Gender: M; age 67; autorefraction: +4.25 -3.5 x 103
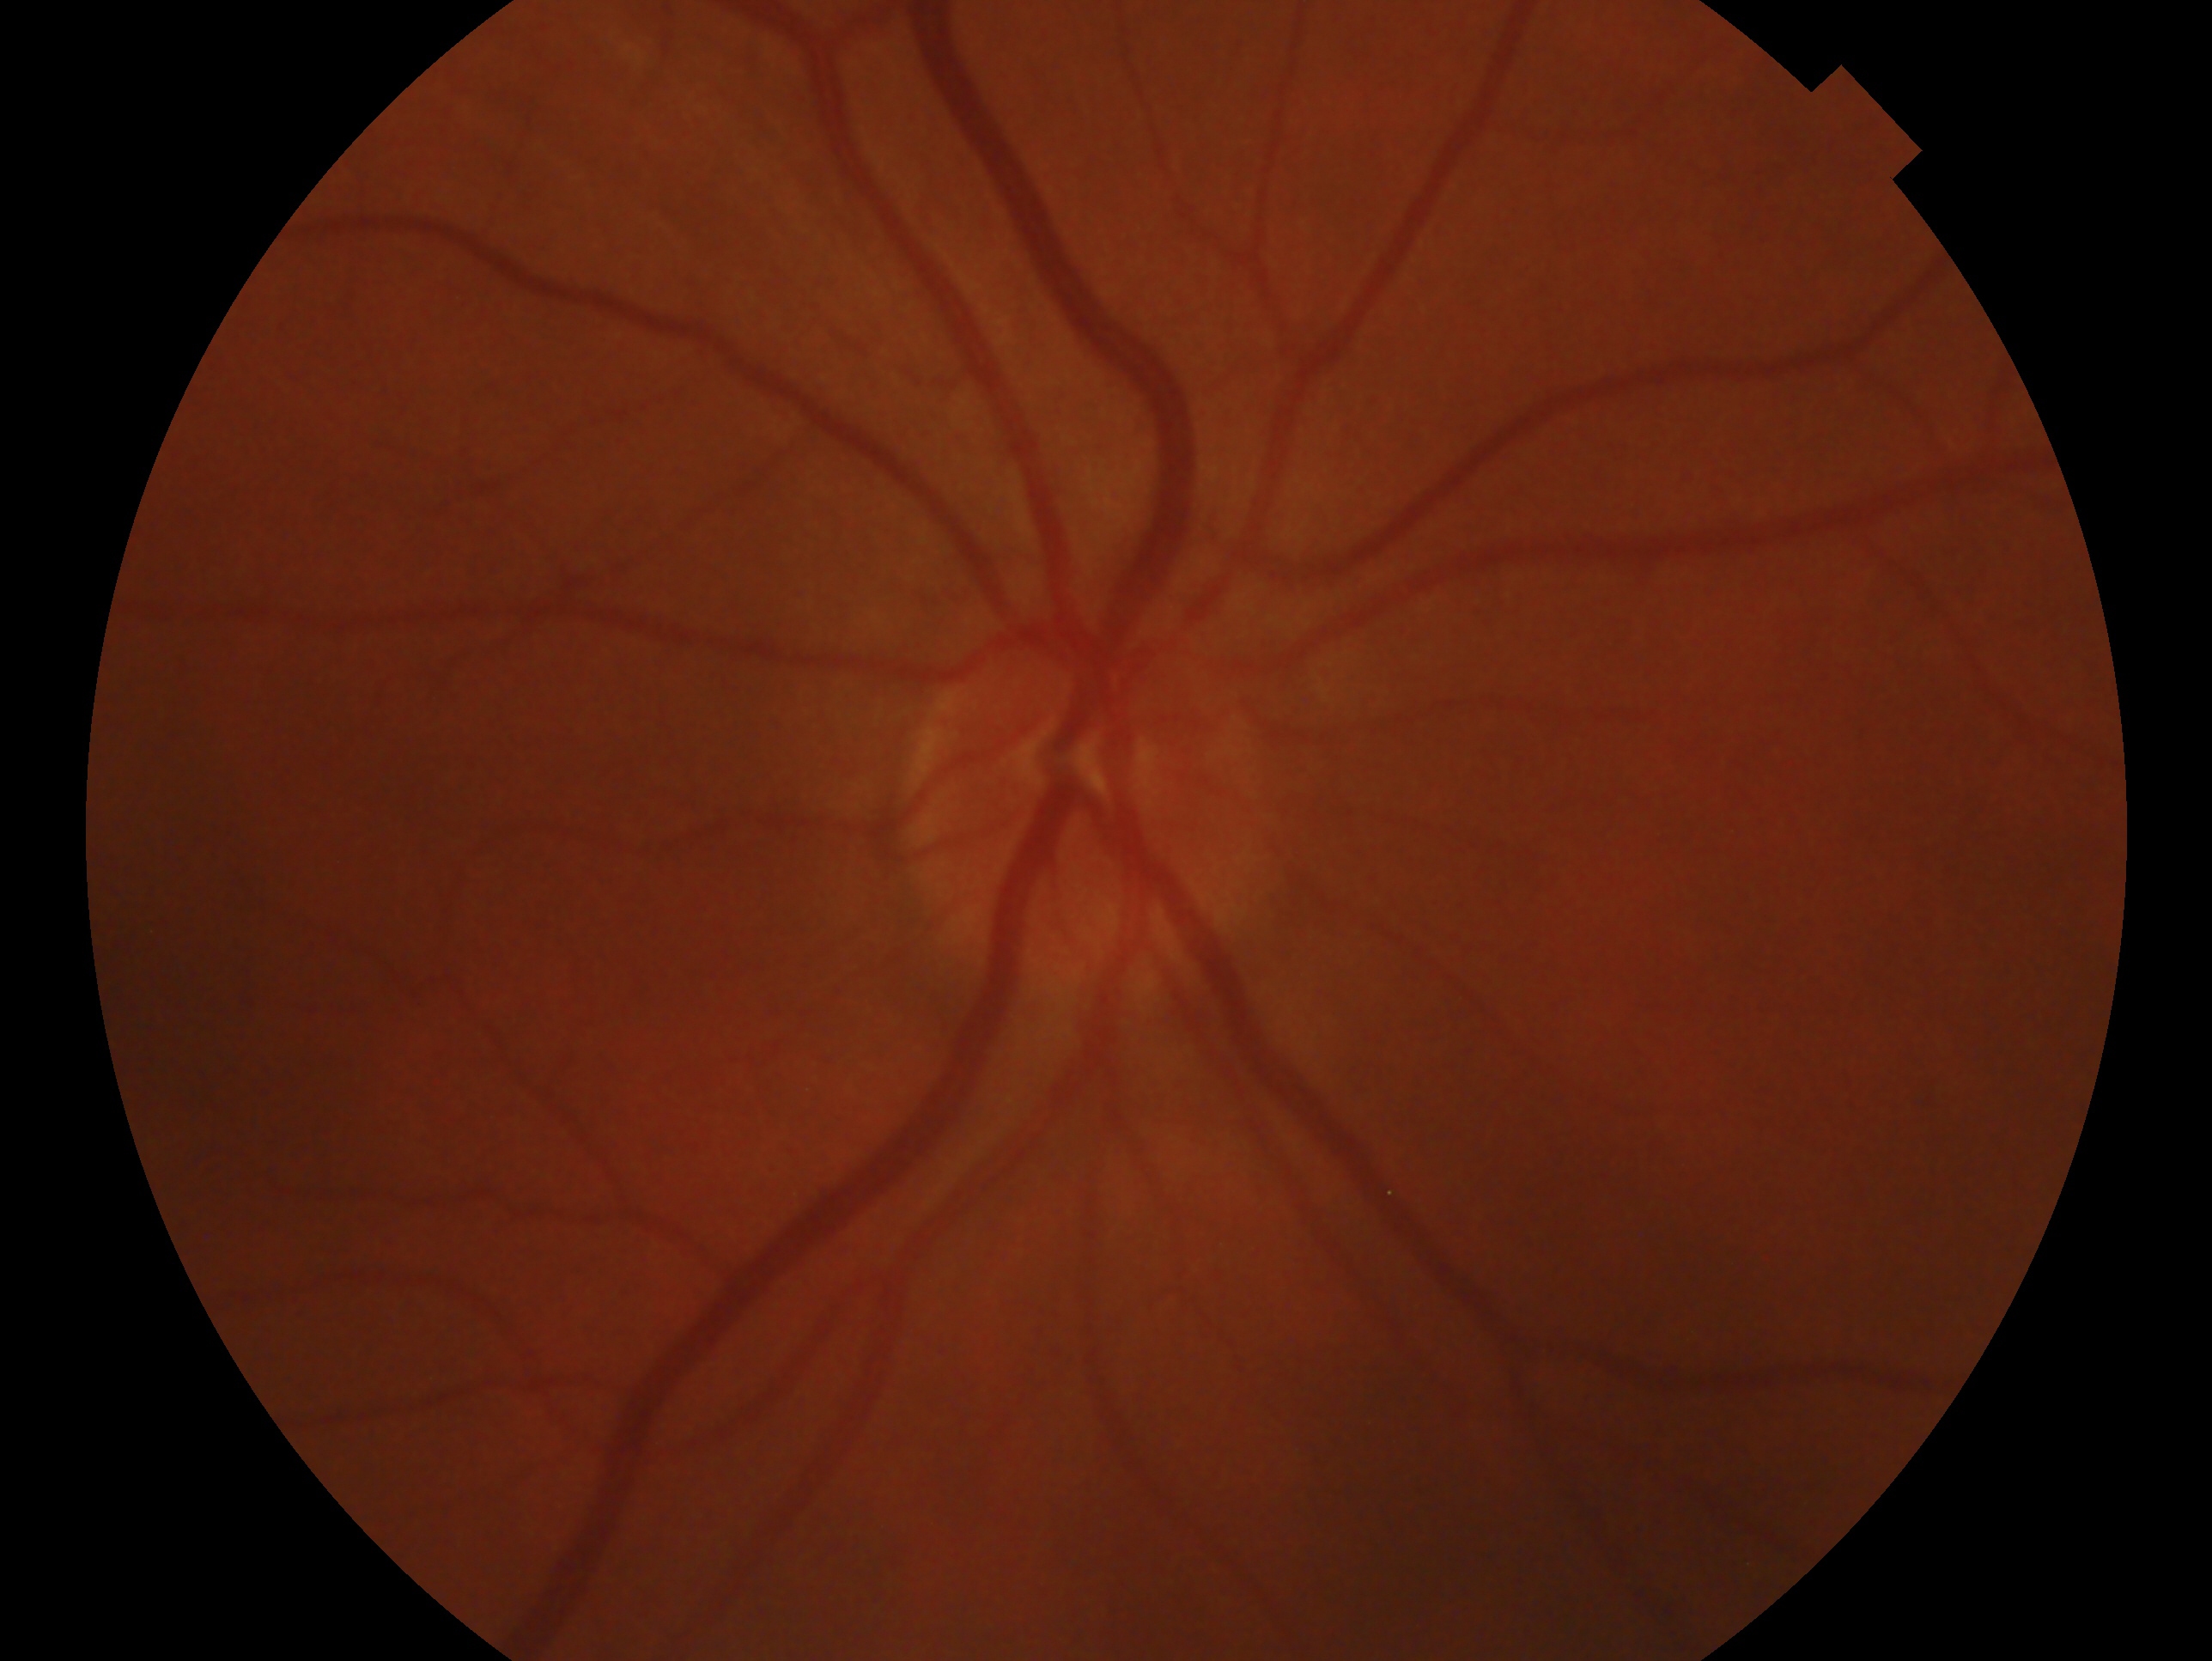

The image shows the OD.
Impression: no glaucoma.